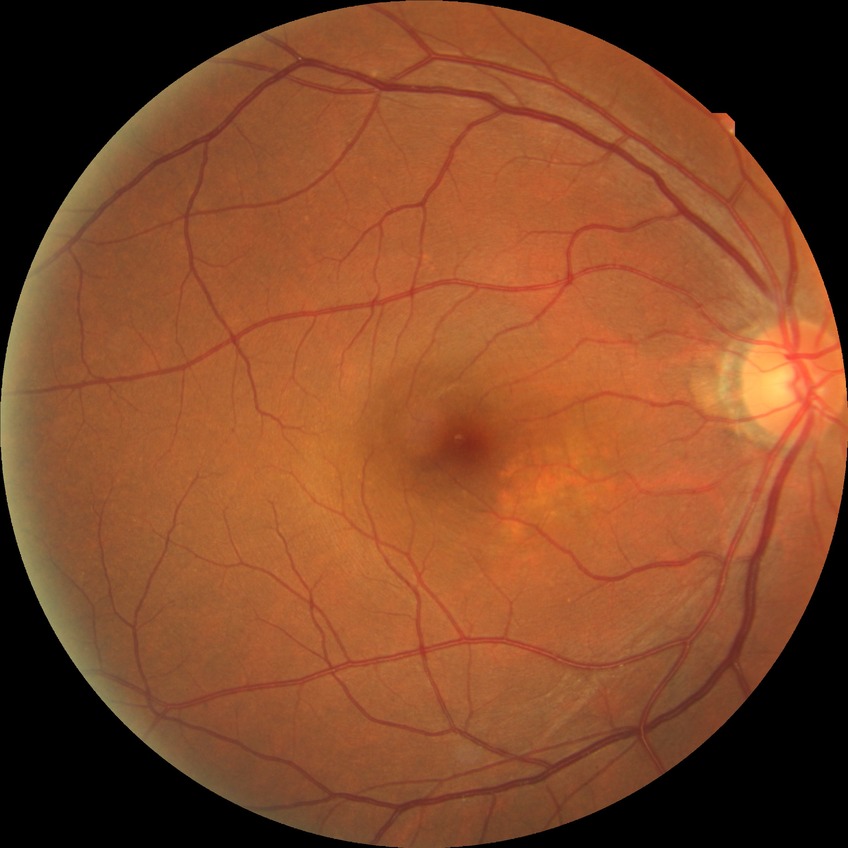

diabetic retinopathy (DR)=no diabetic retinopathy (NDR).